Color fundus photograph — 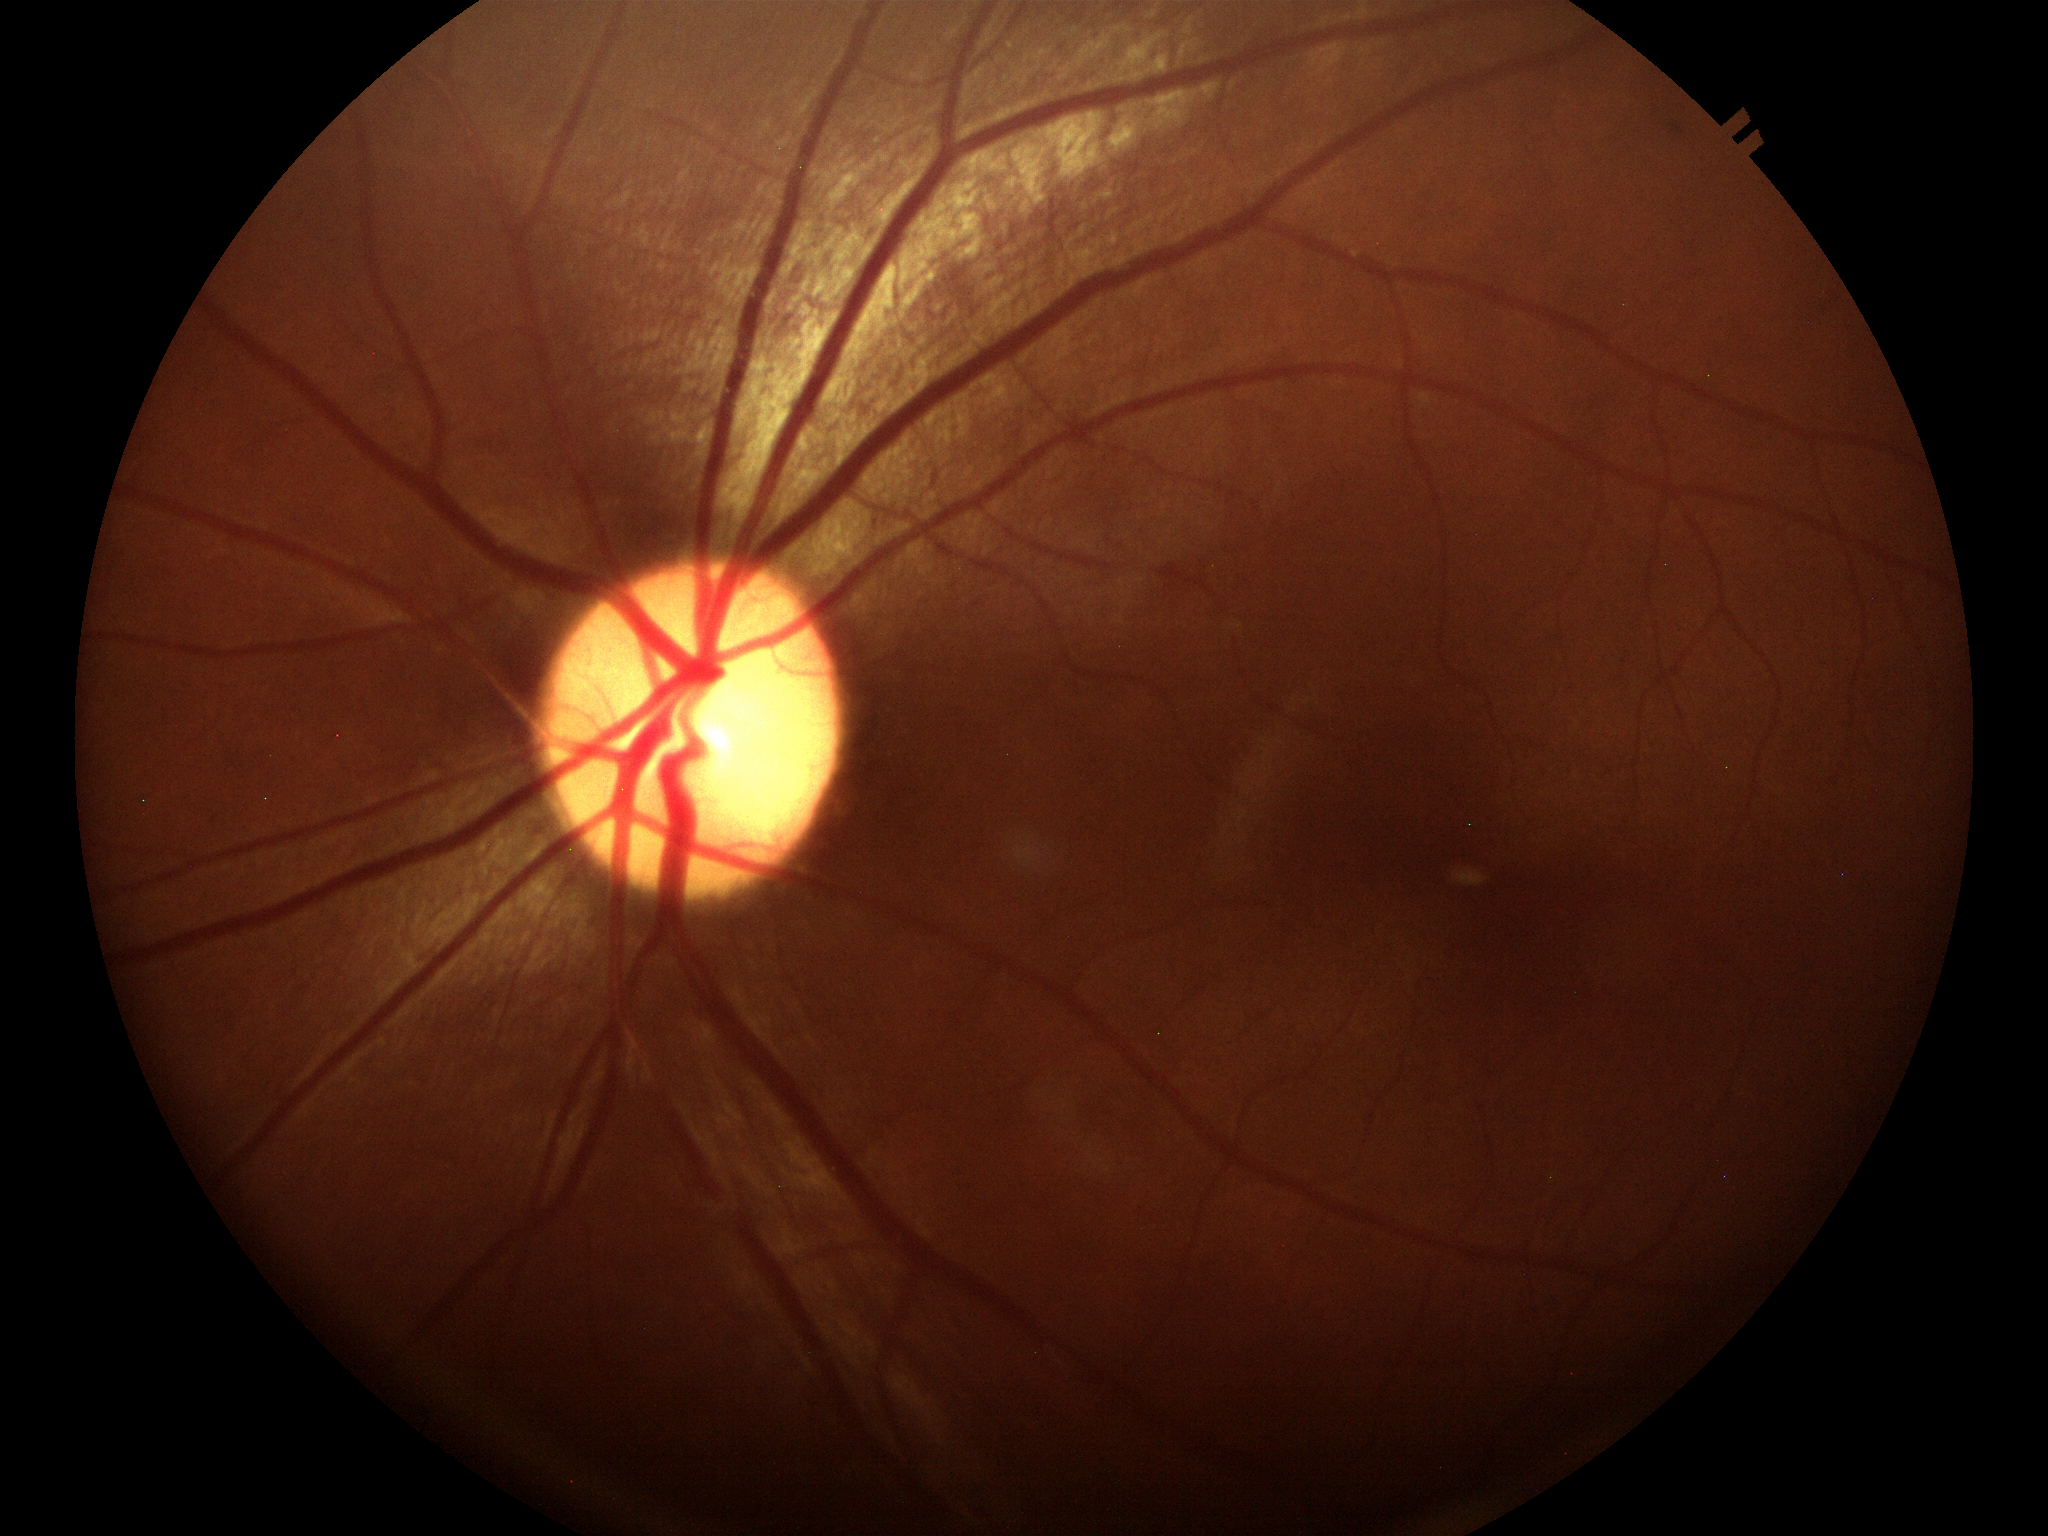

• vertical cup-disc ratio: 0.55
• Glaucoma evaluation: negative